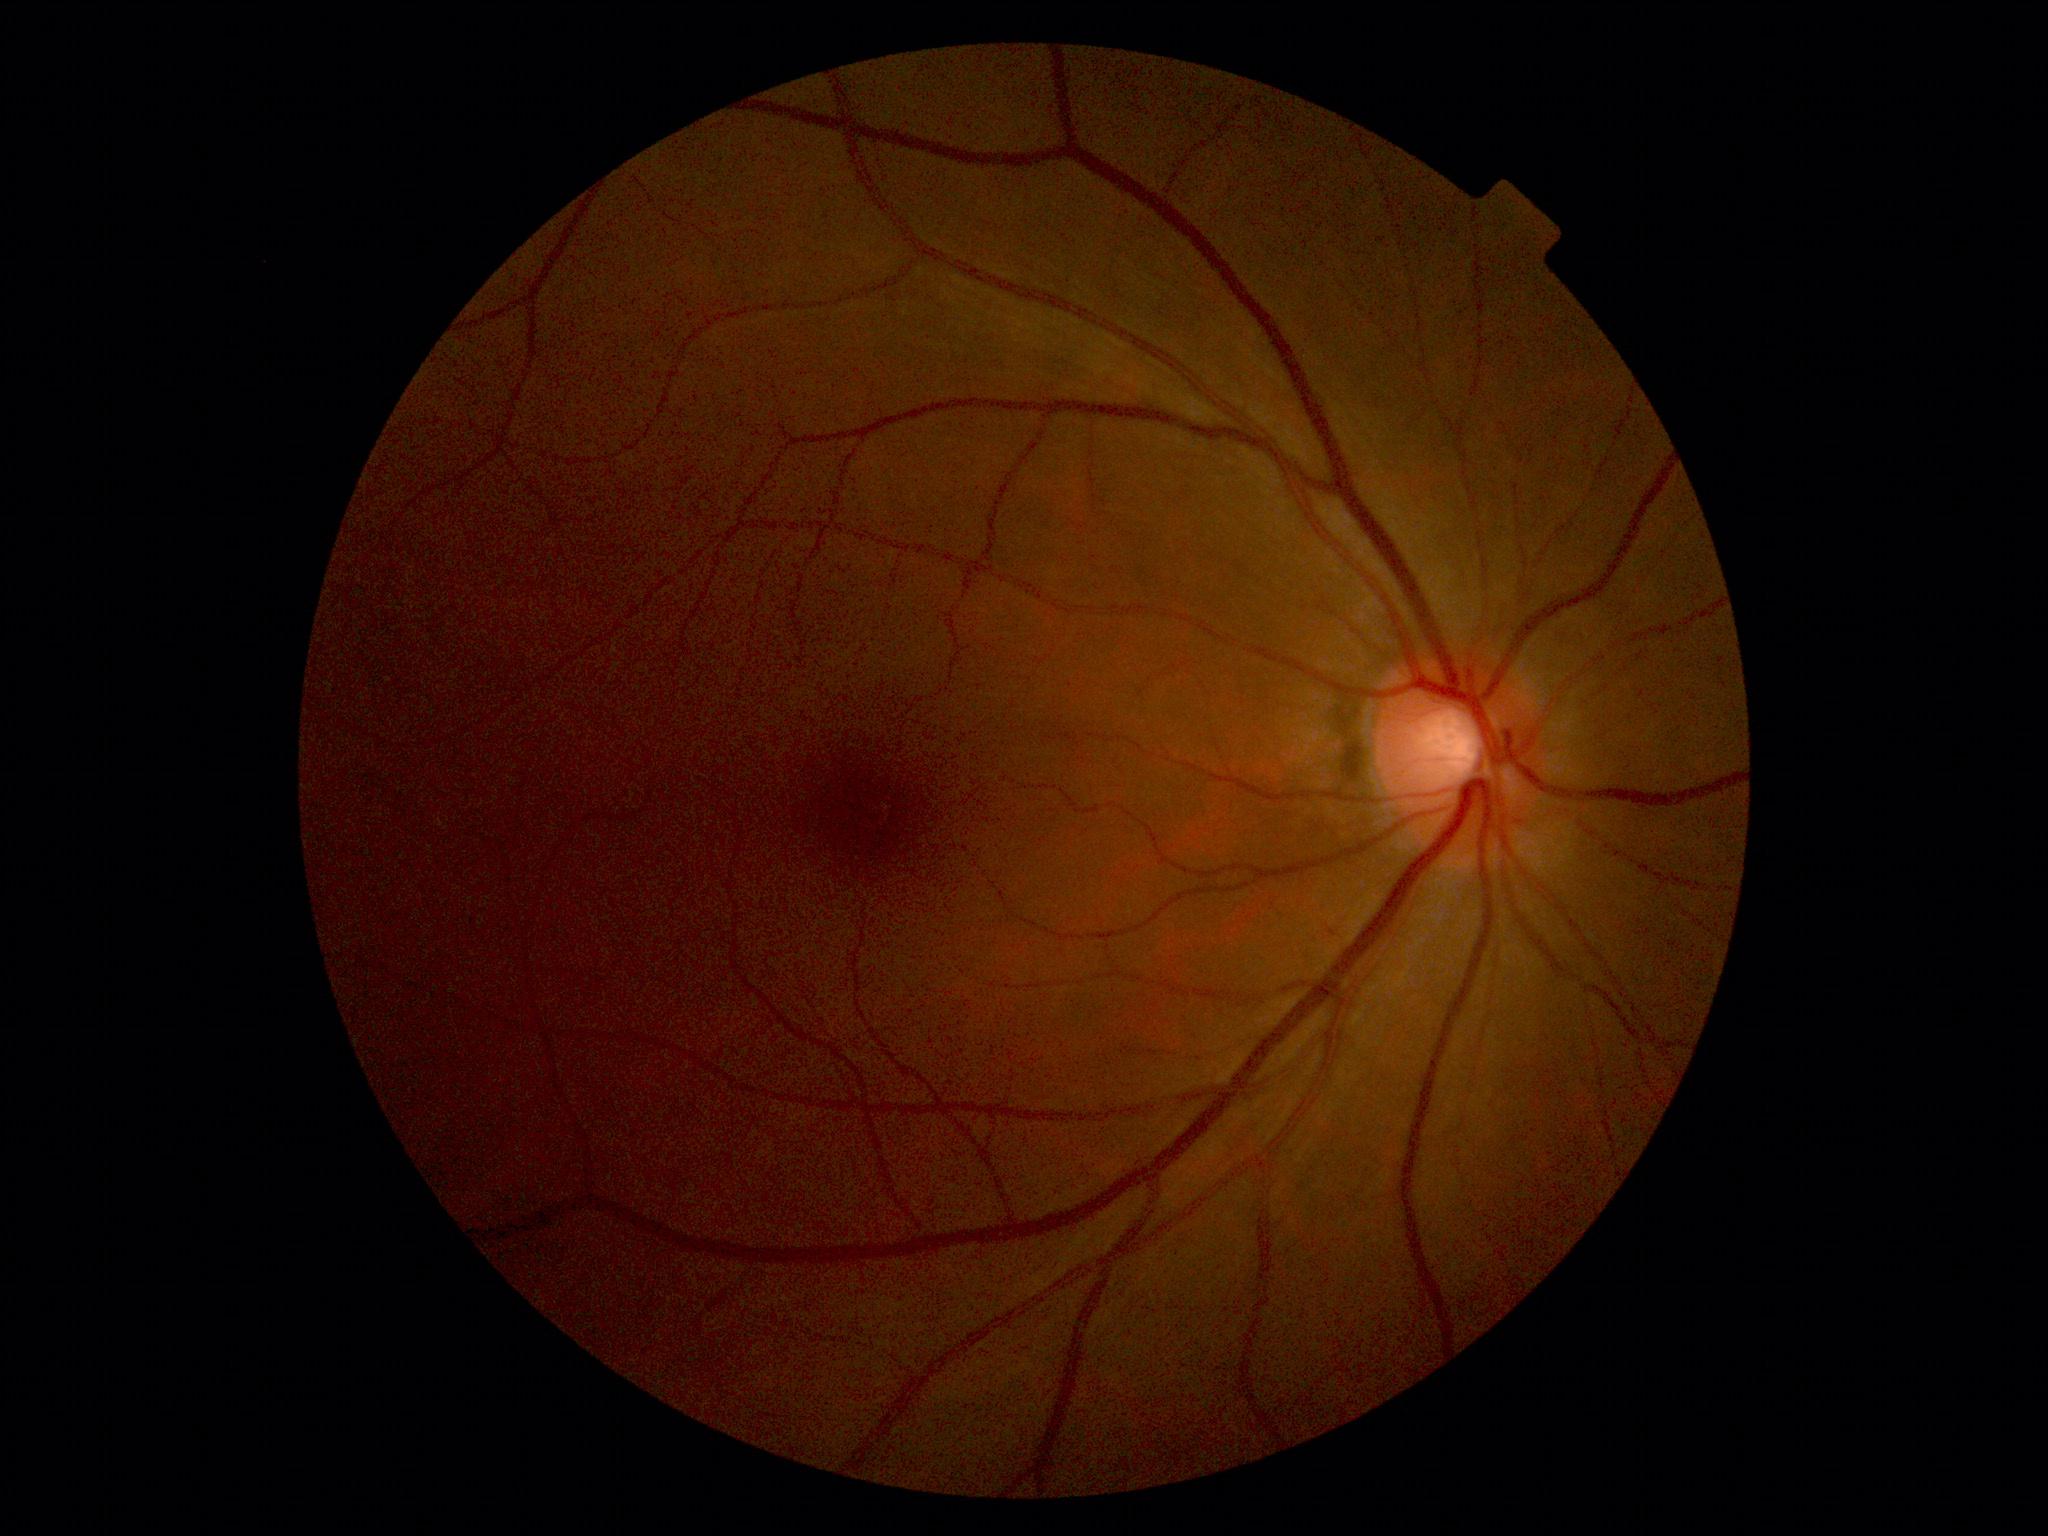 DR severity: 0/4 — no visible signs of diabetic retinopathy.